Graded on the modified Davis scale — 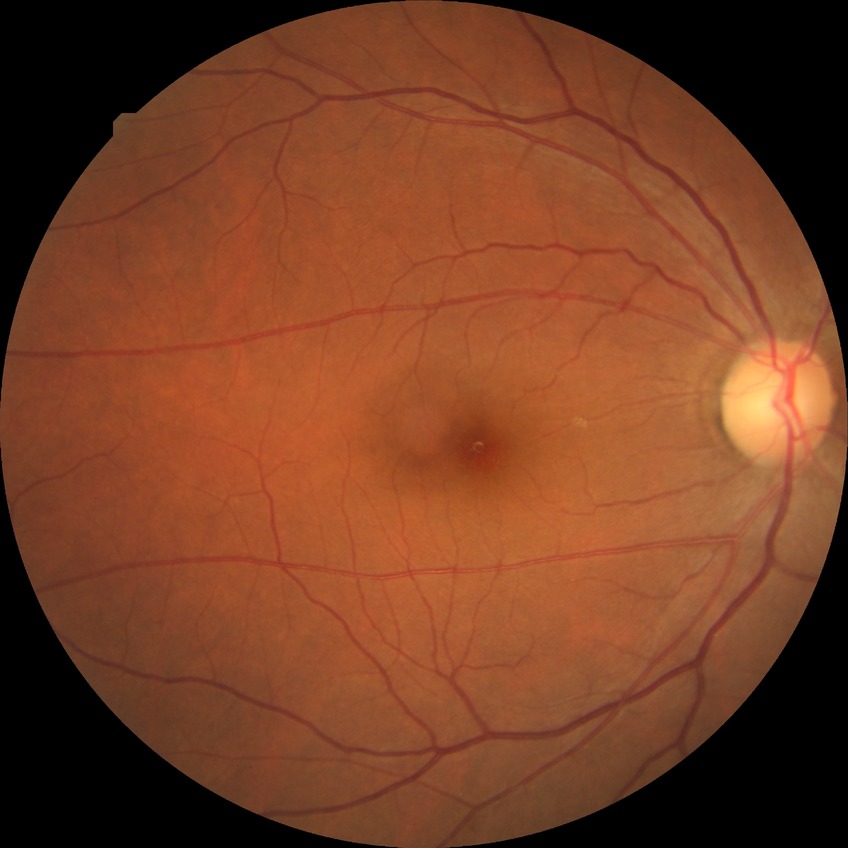 Davis stage is NDR.